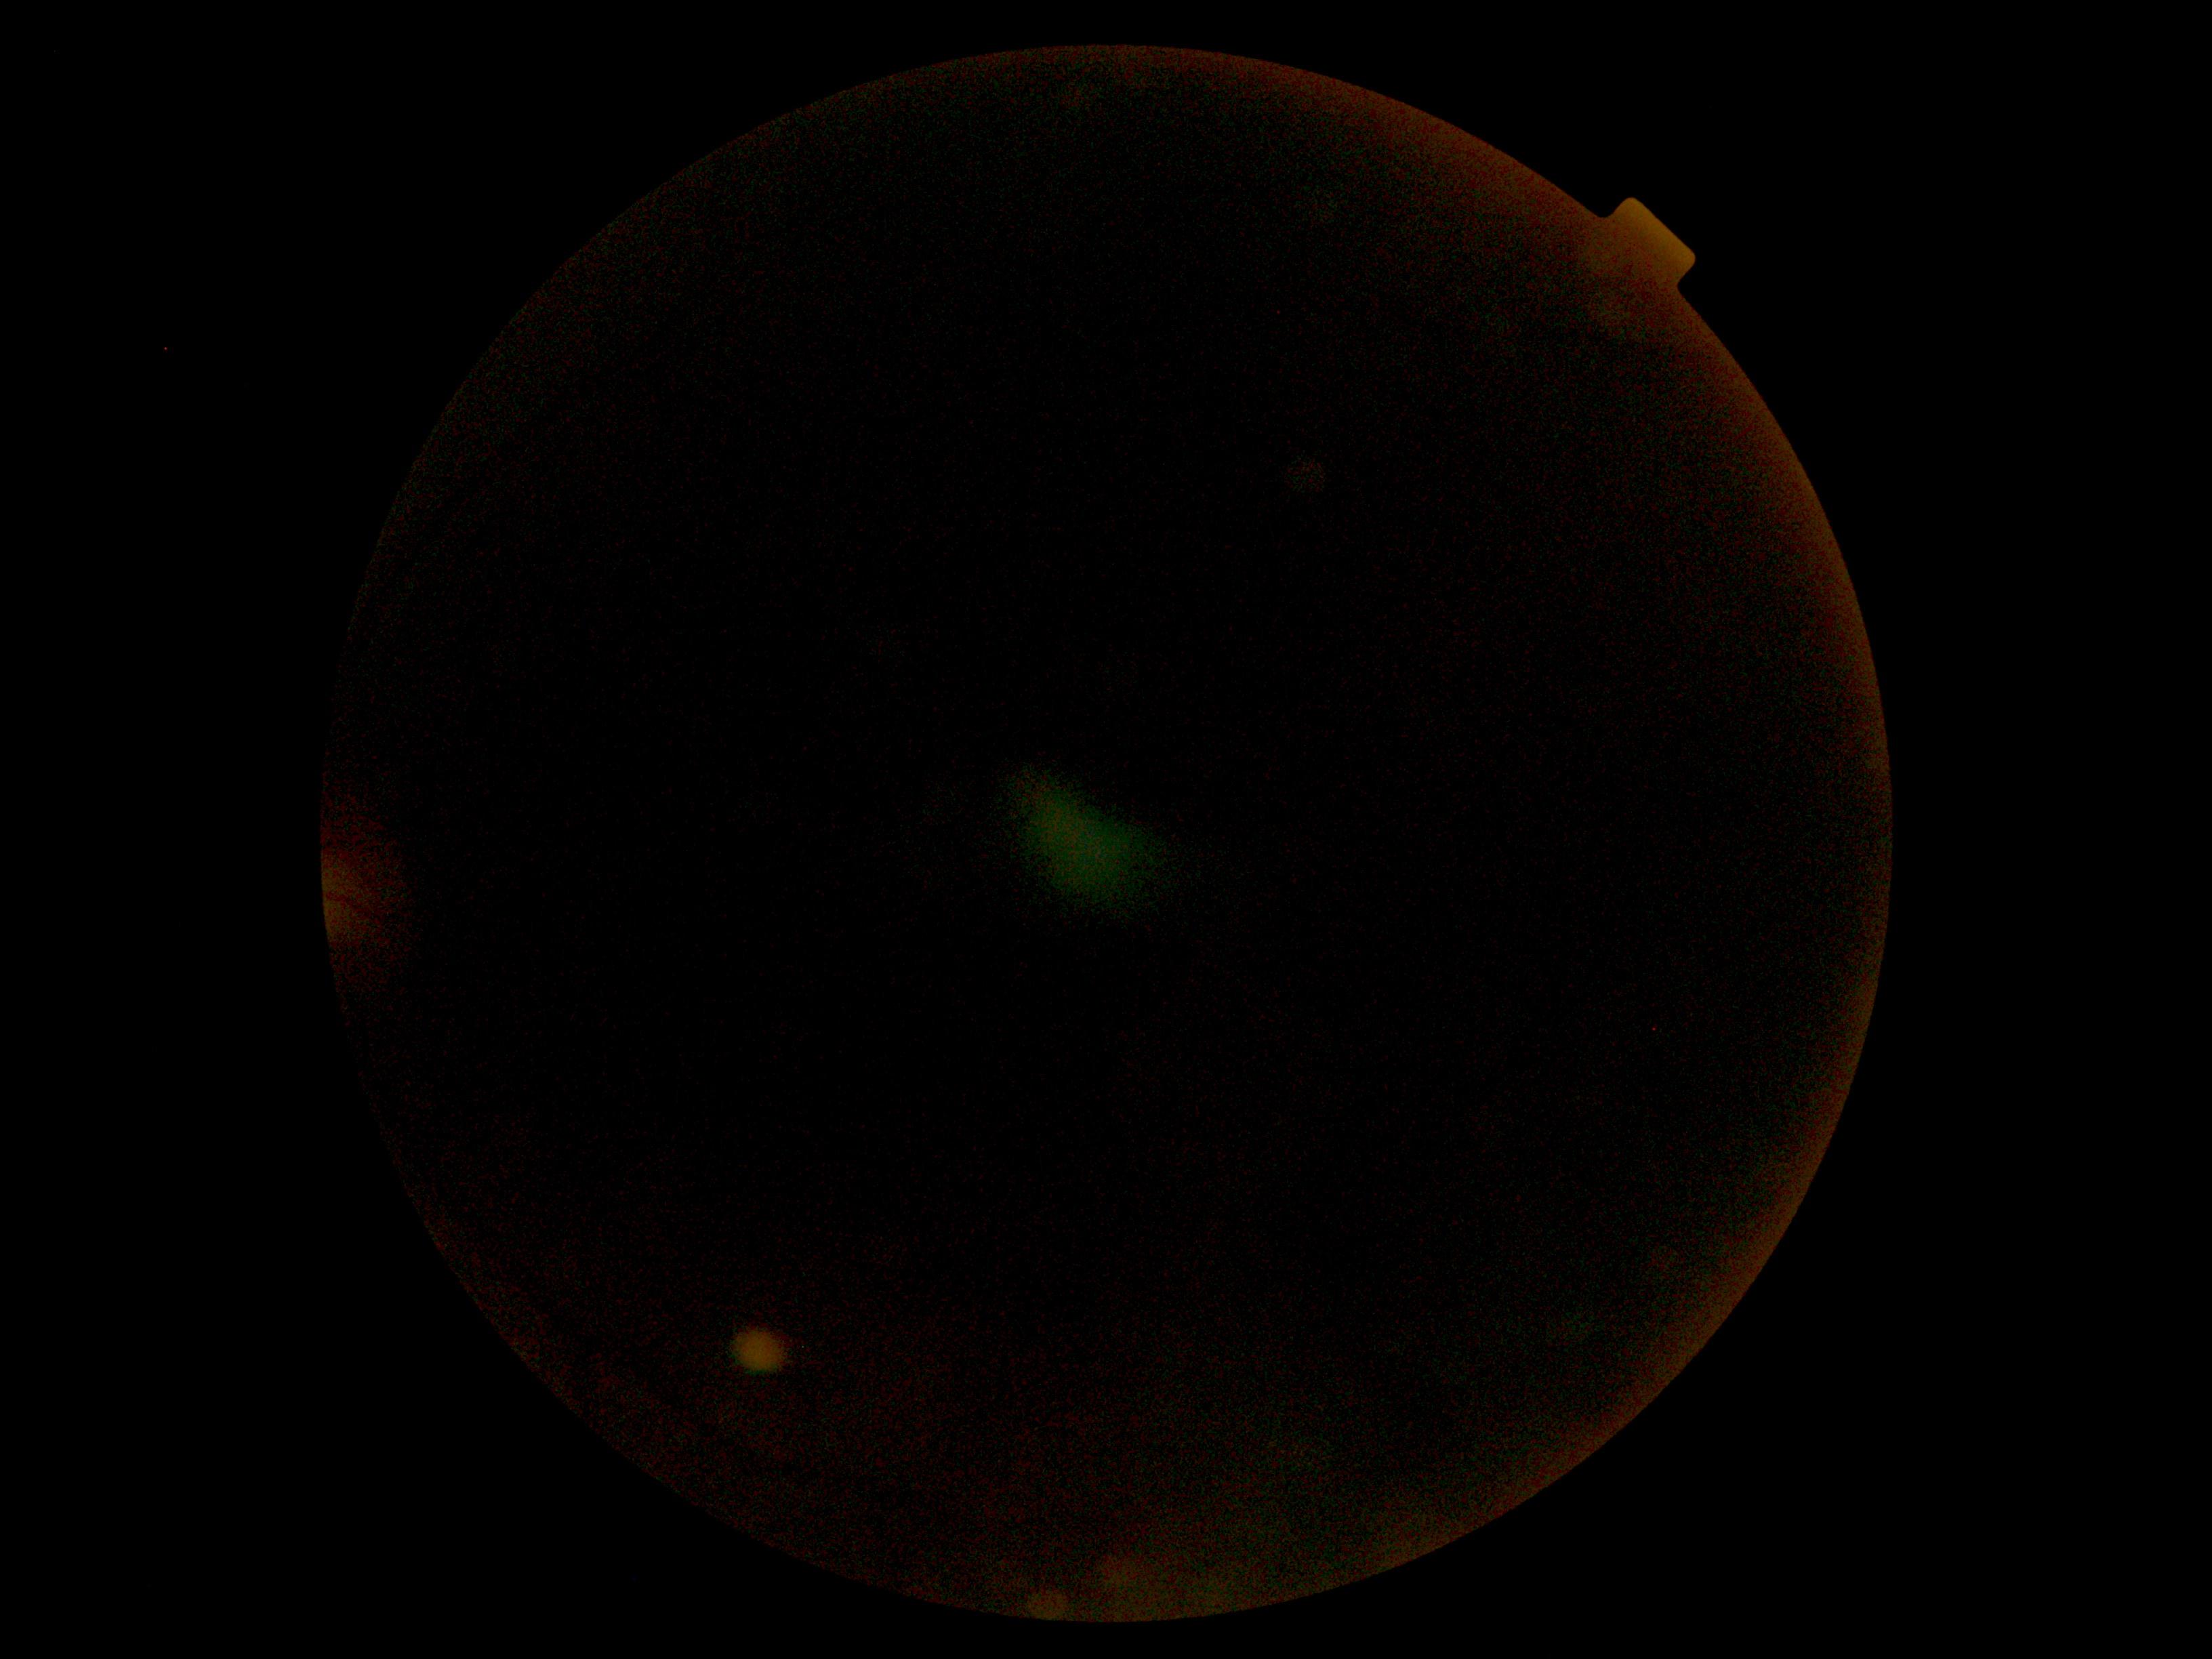

Retinopathy grade is ungradable.